Non-mydriatic acquisition — 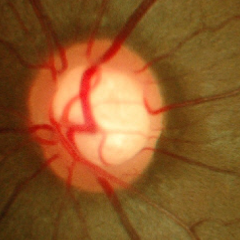

Glaucoma stage: no glaucomatous optic neuropathy.